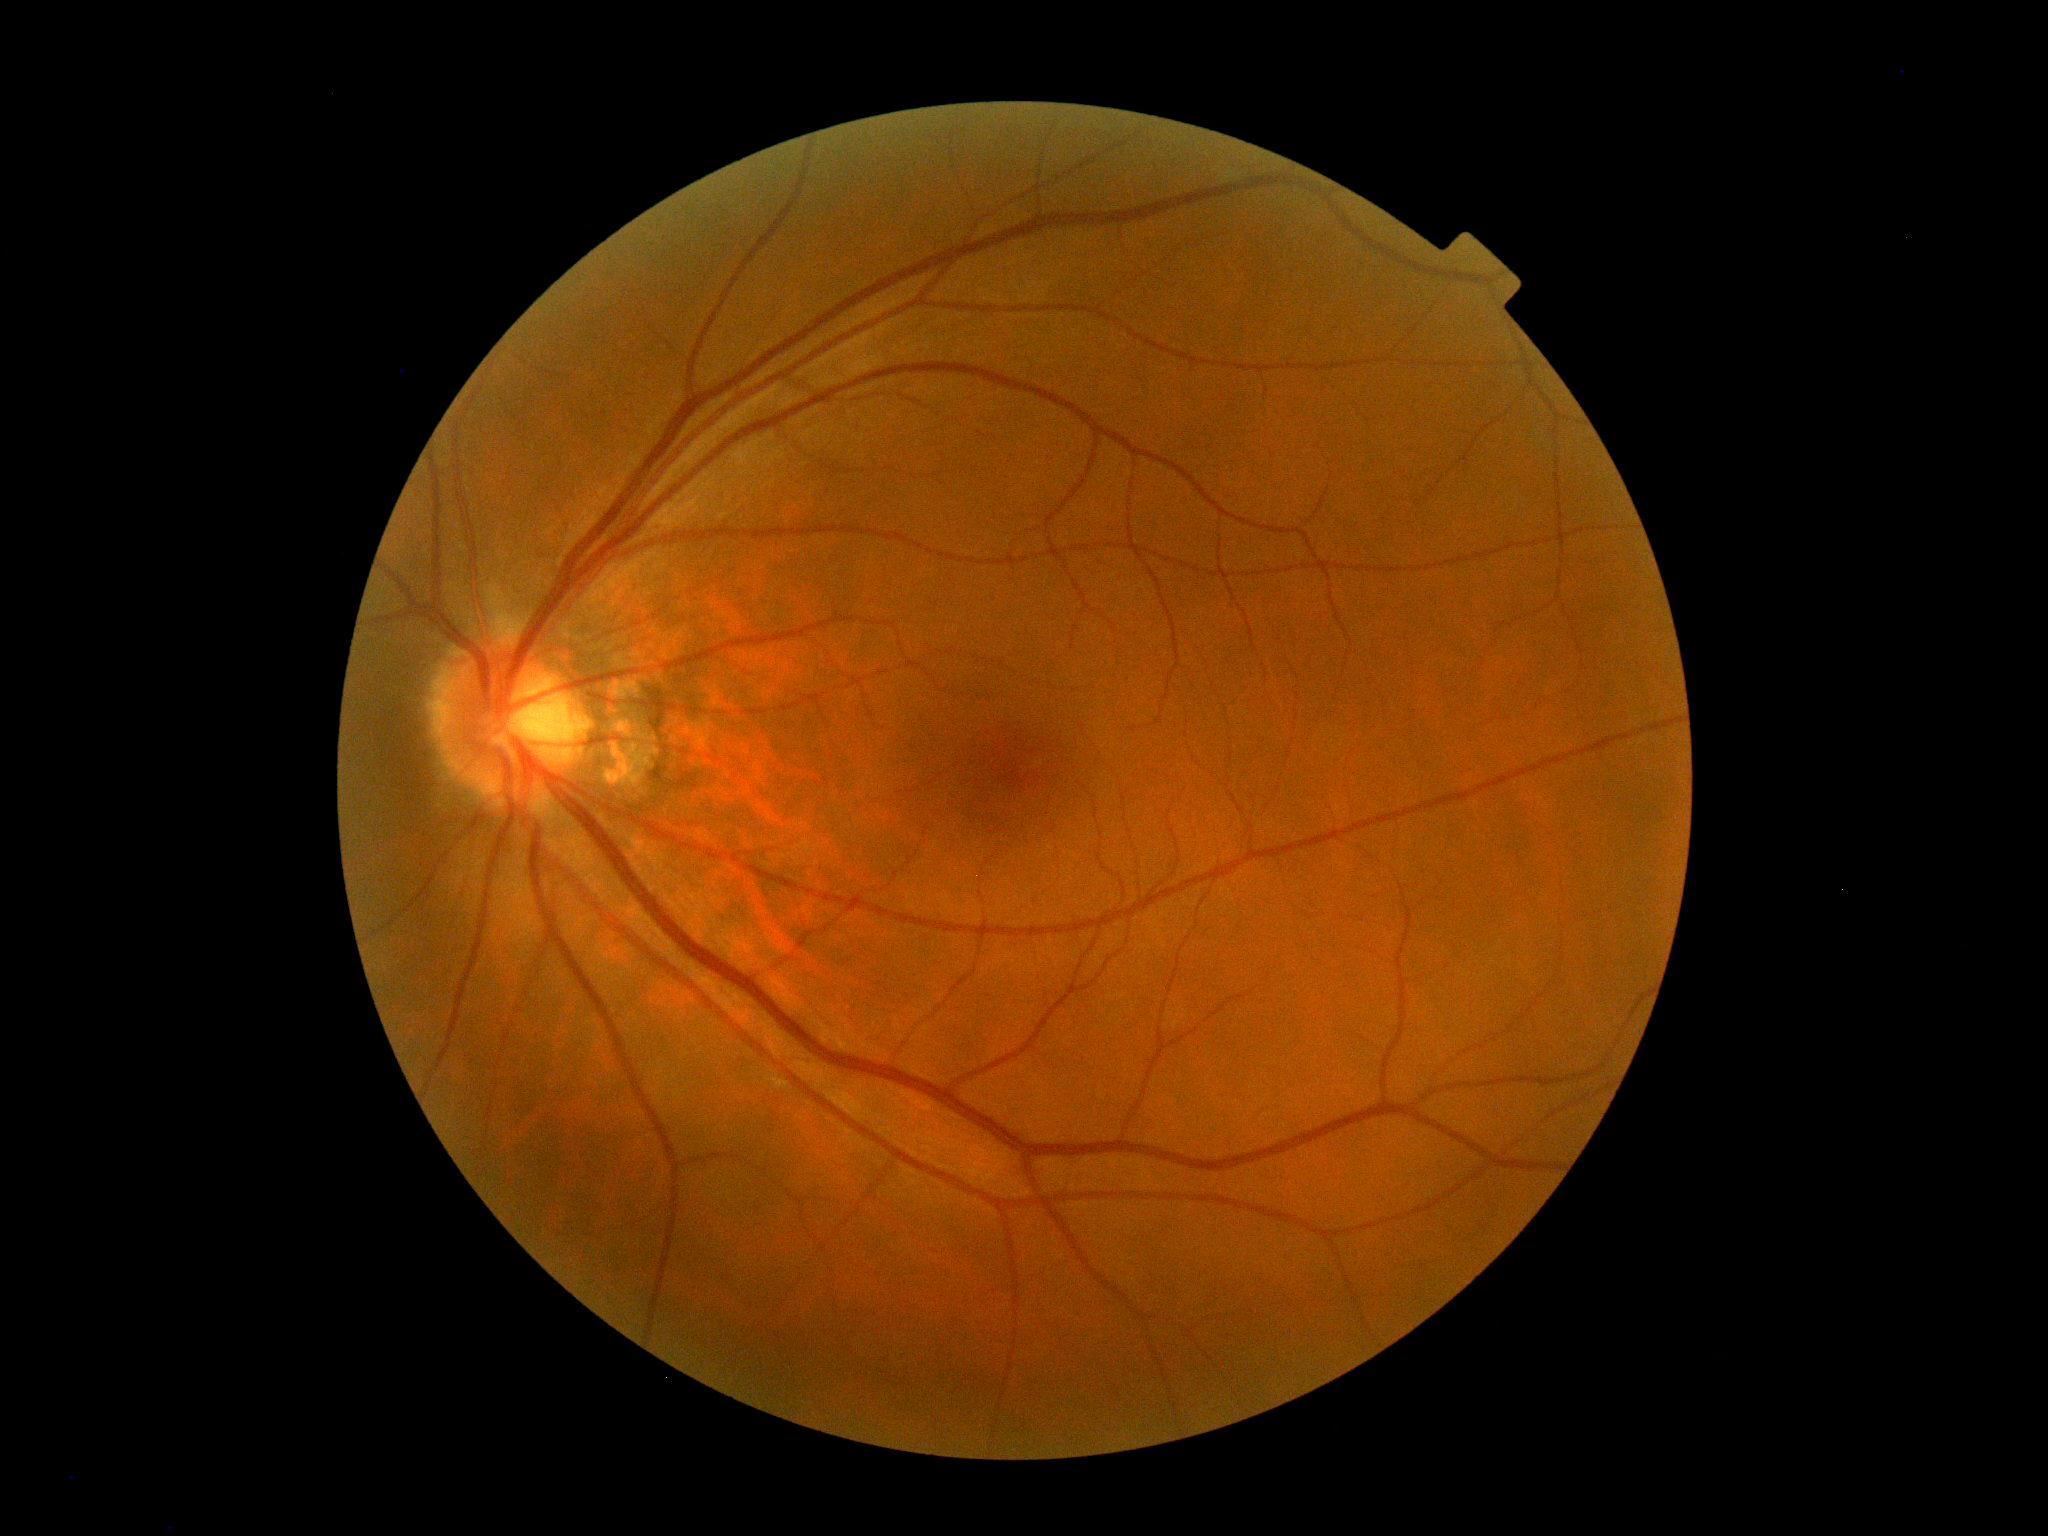 DR impression = no apparent DR, diabetic retinopathy (DR) = 0/4.